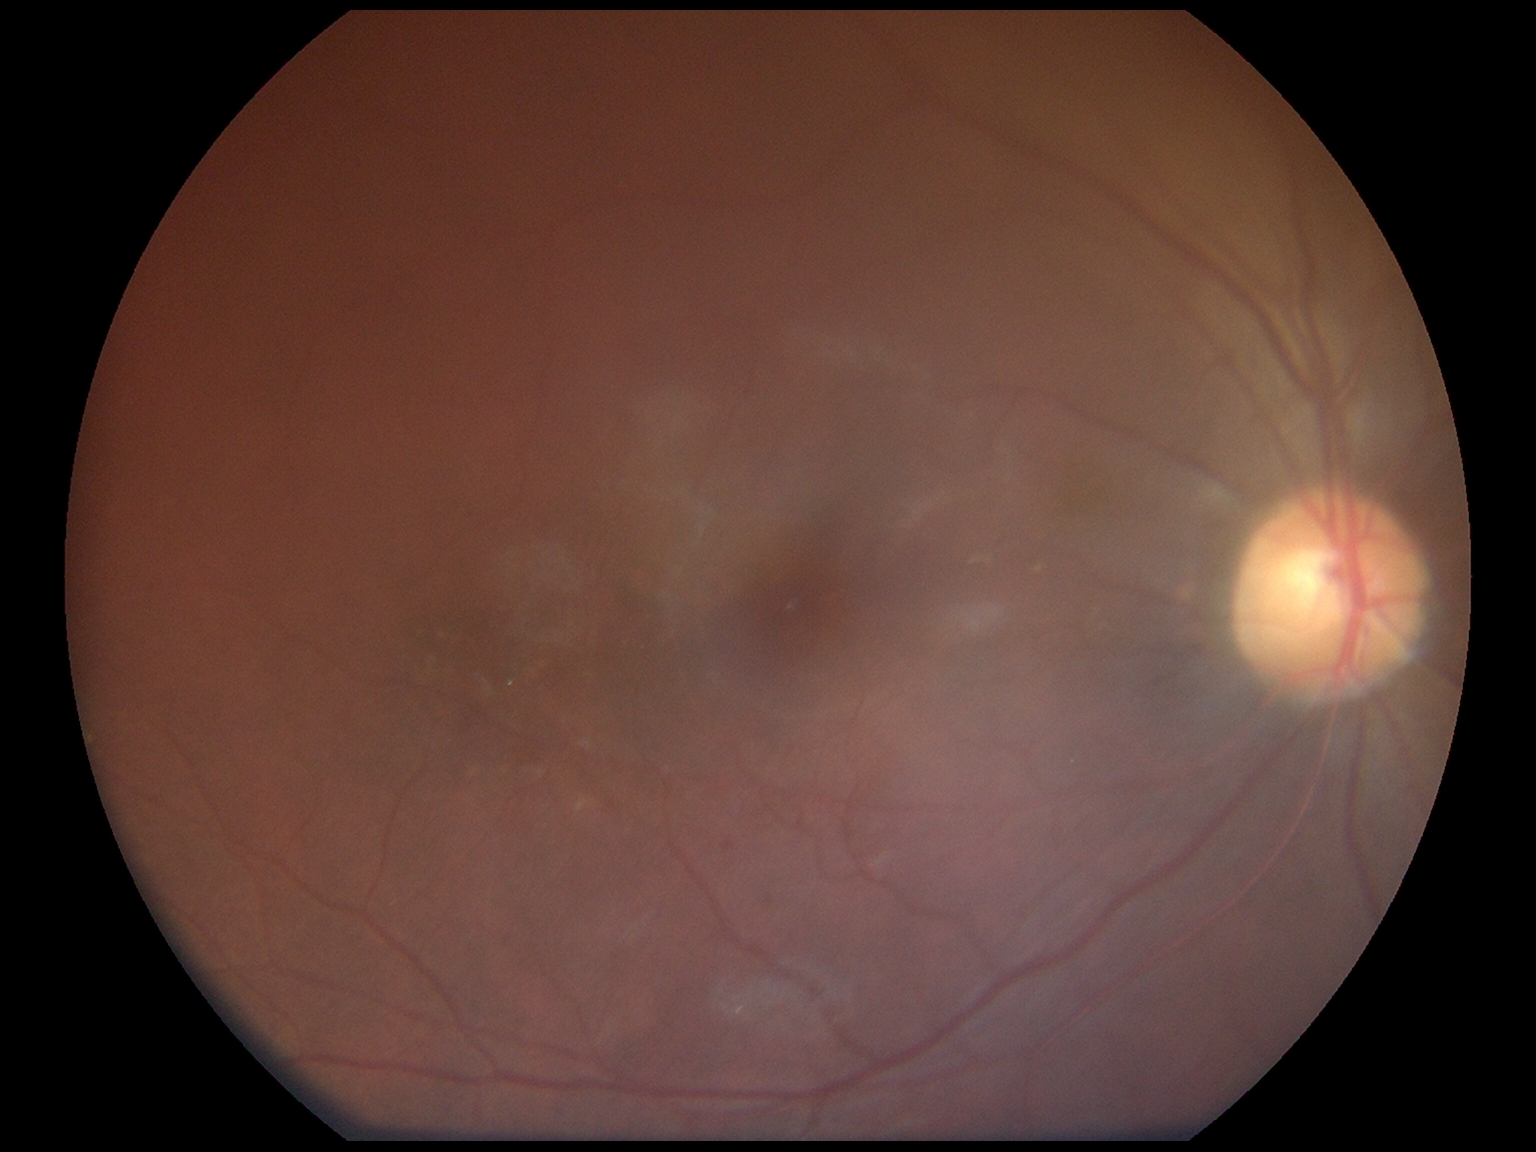

Findings:
• DR grade: 1 (mild NPDR)